Fundus photo: 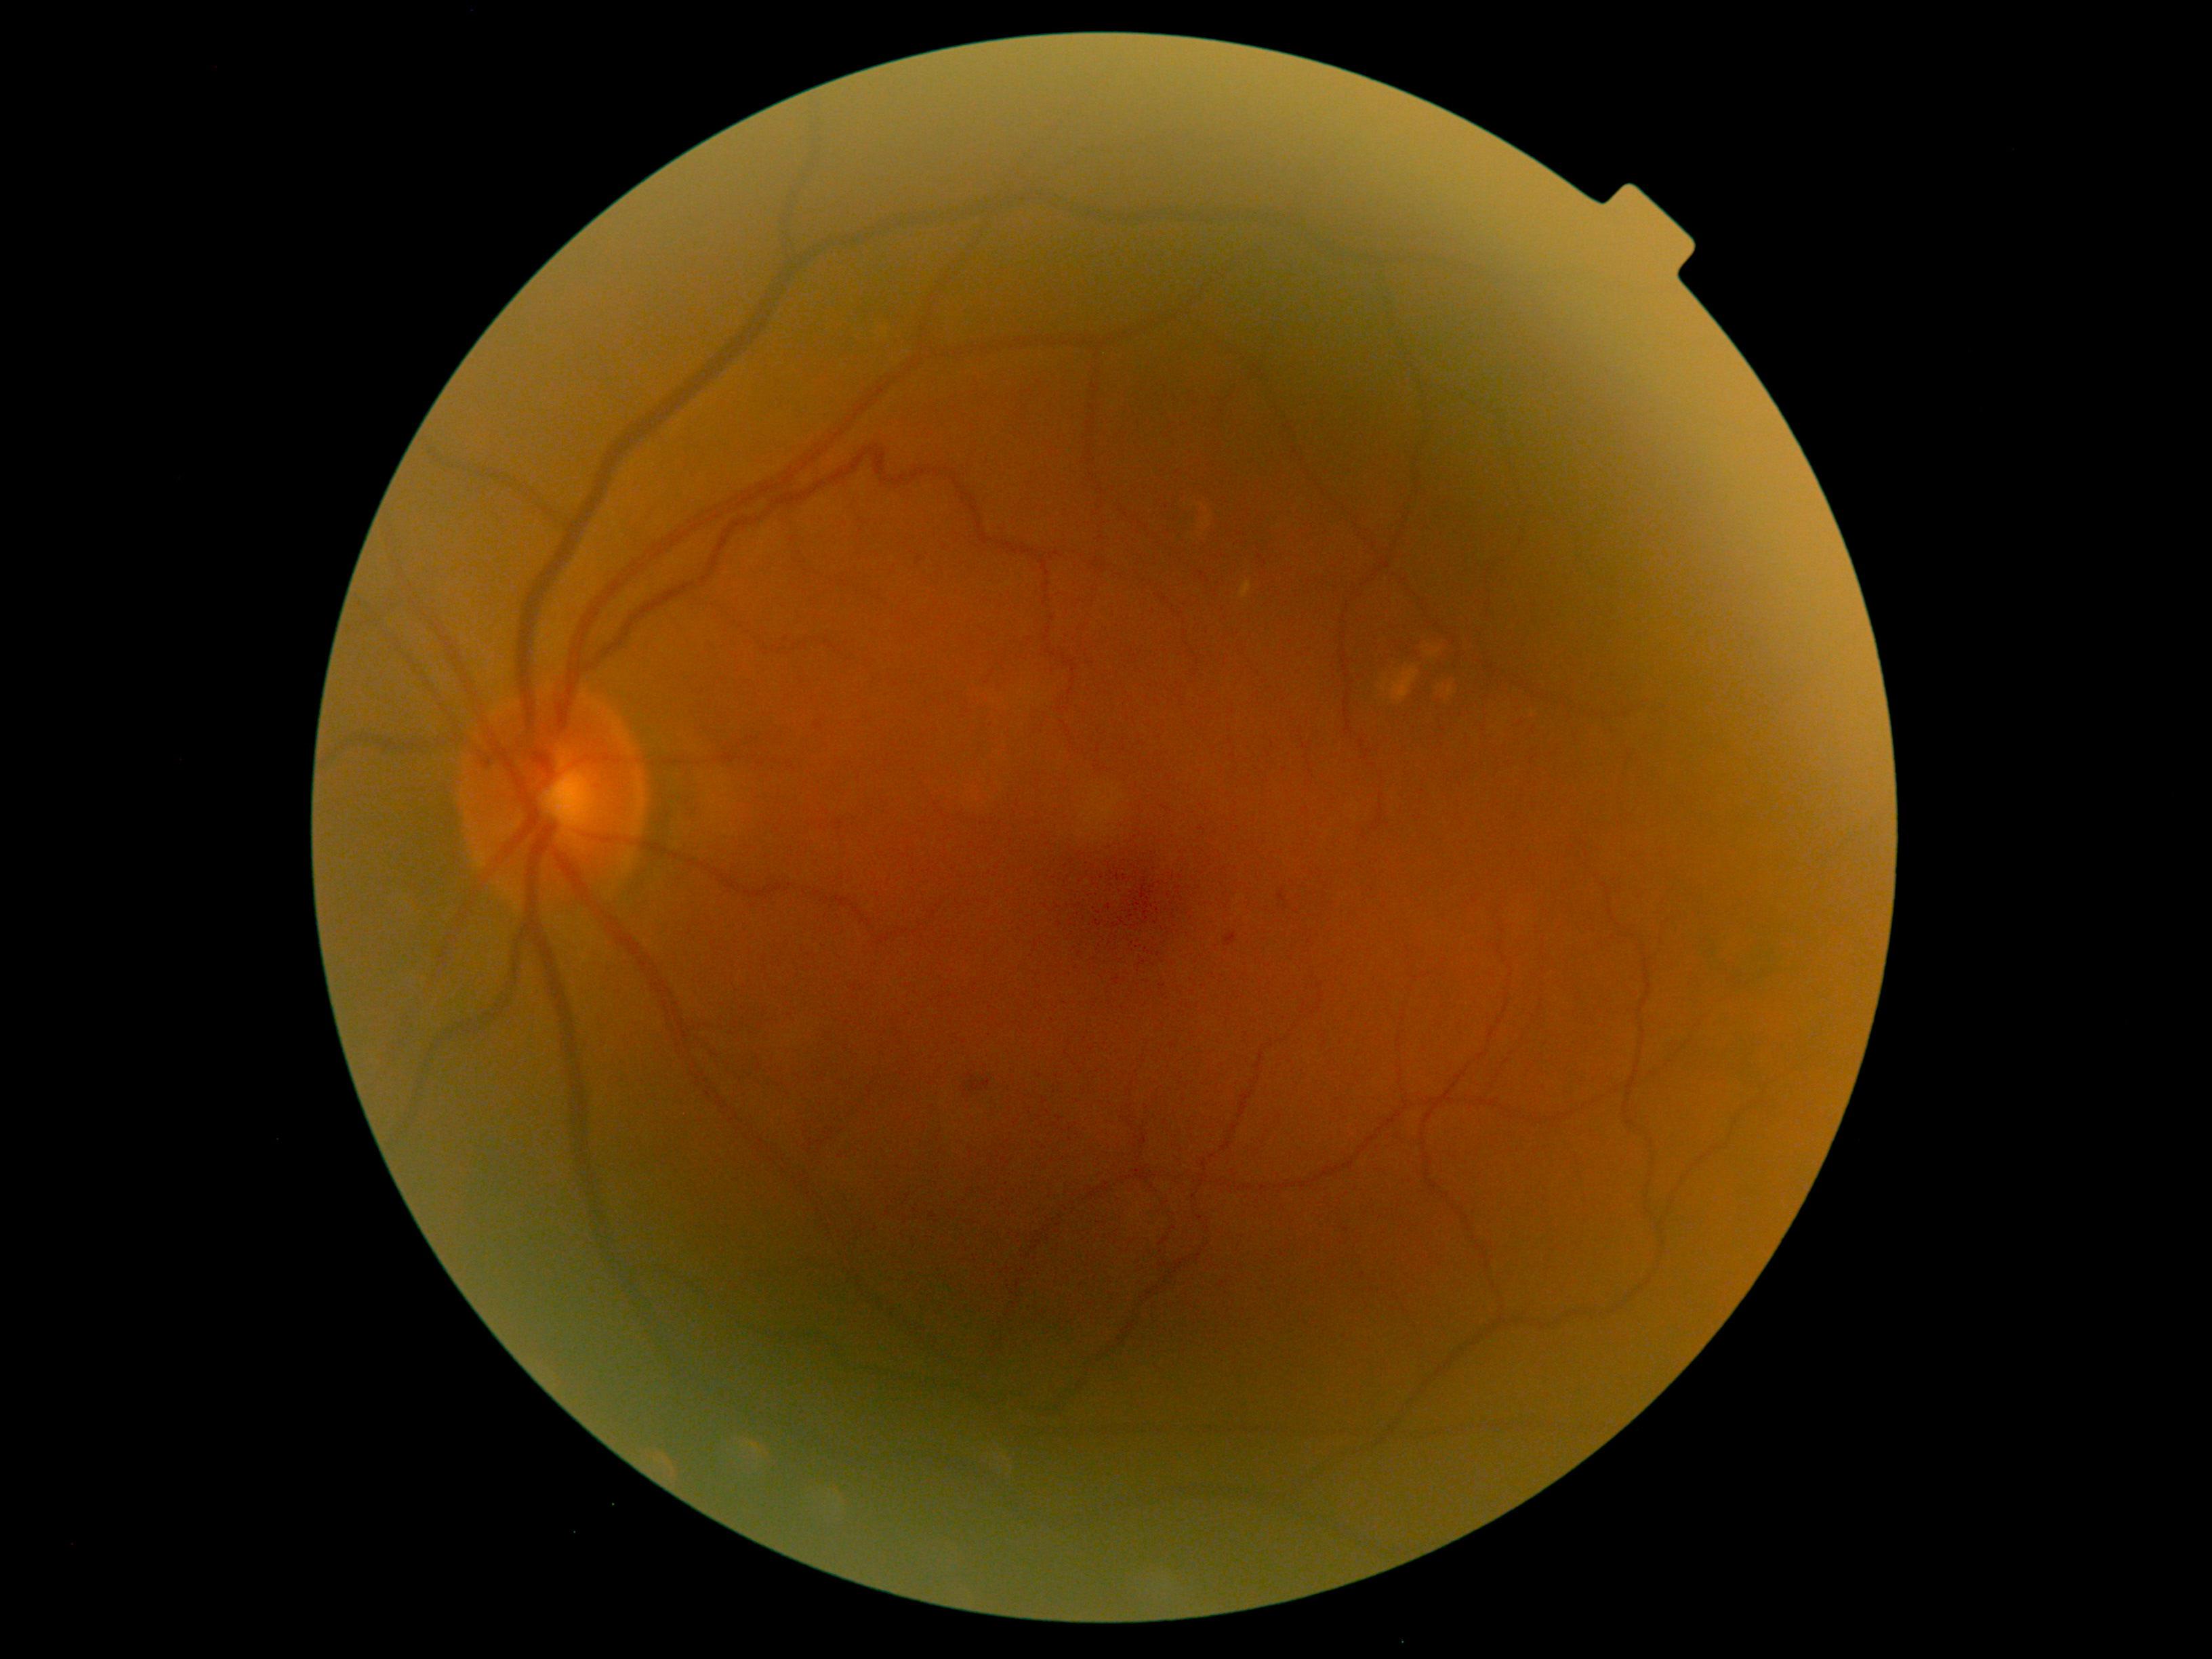

Retinopathy grade is 1.